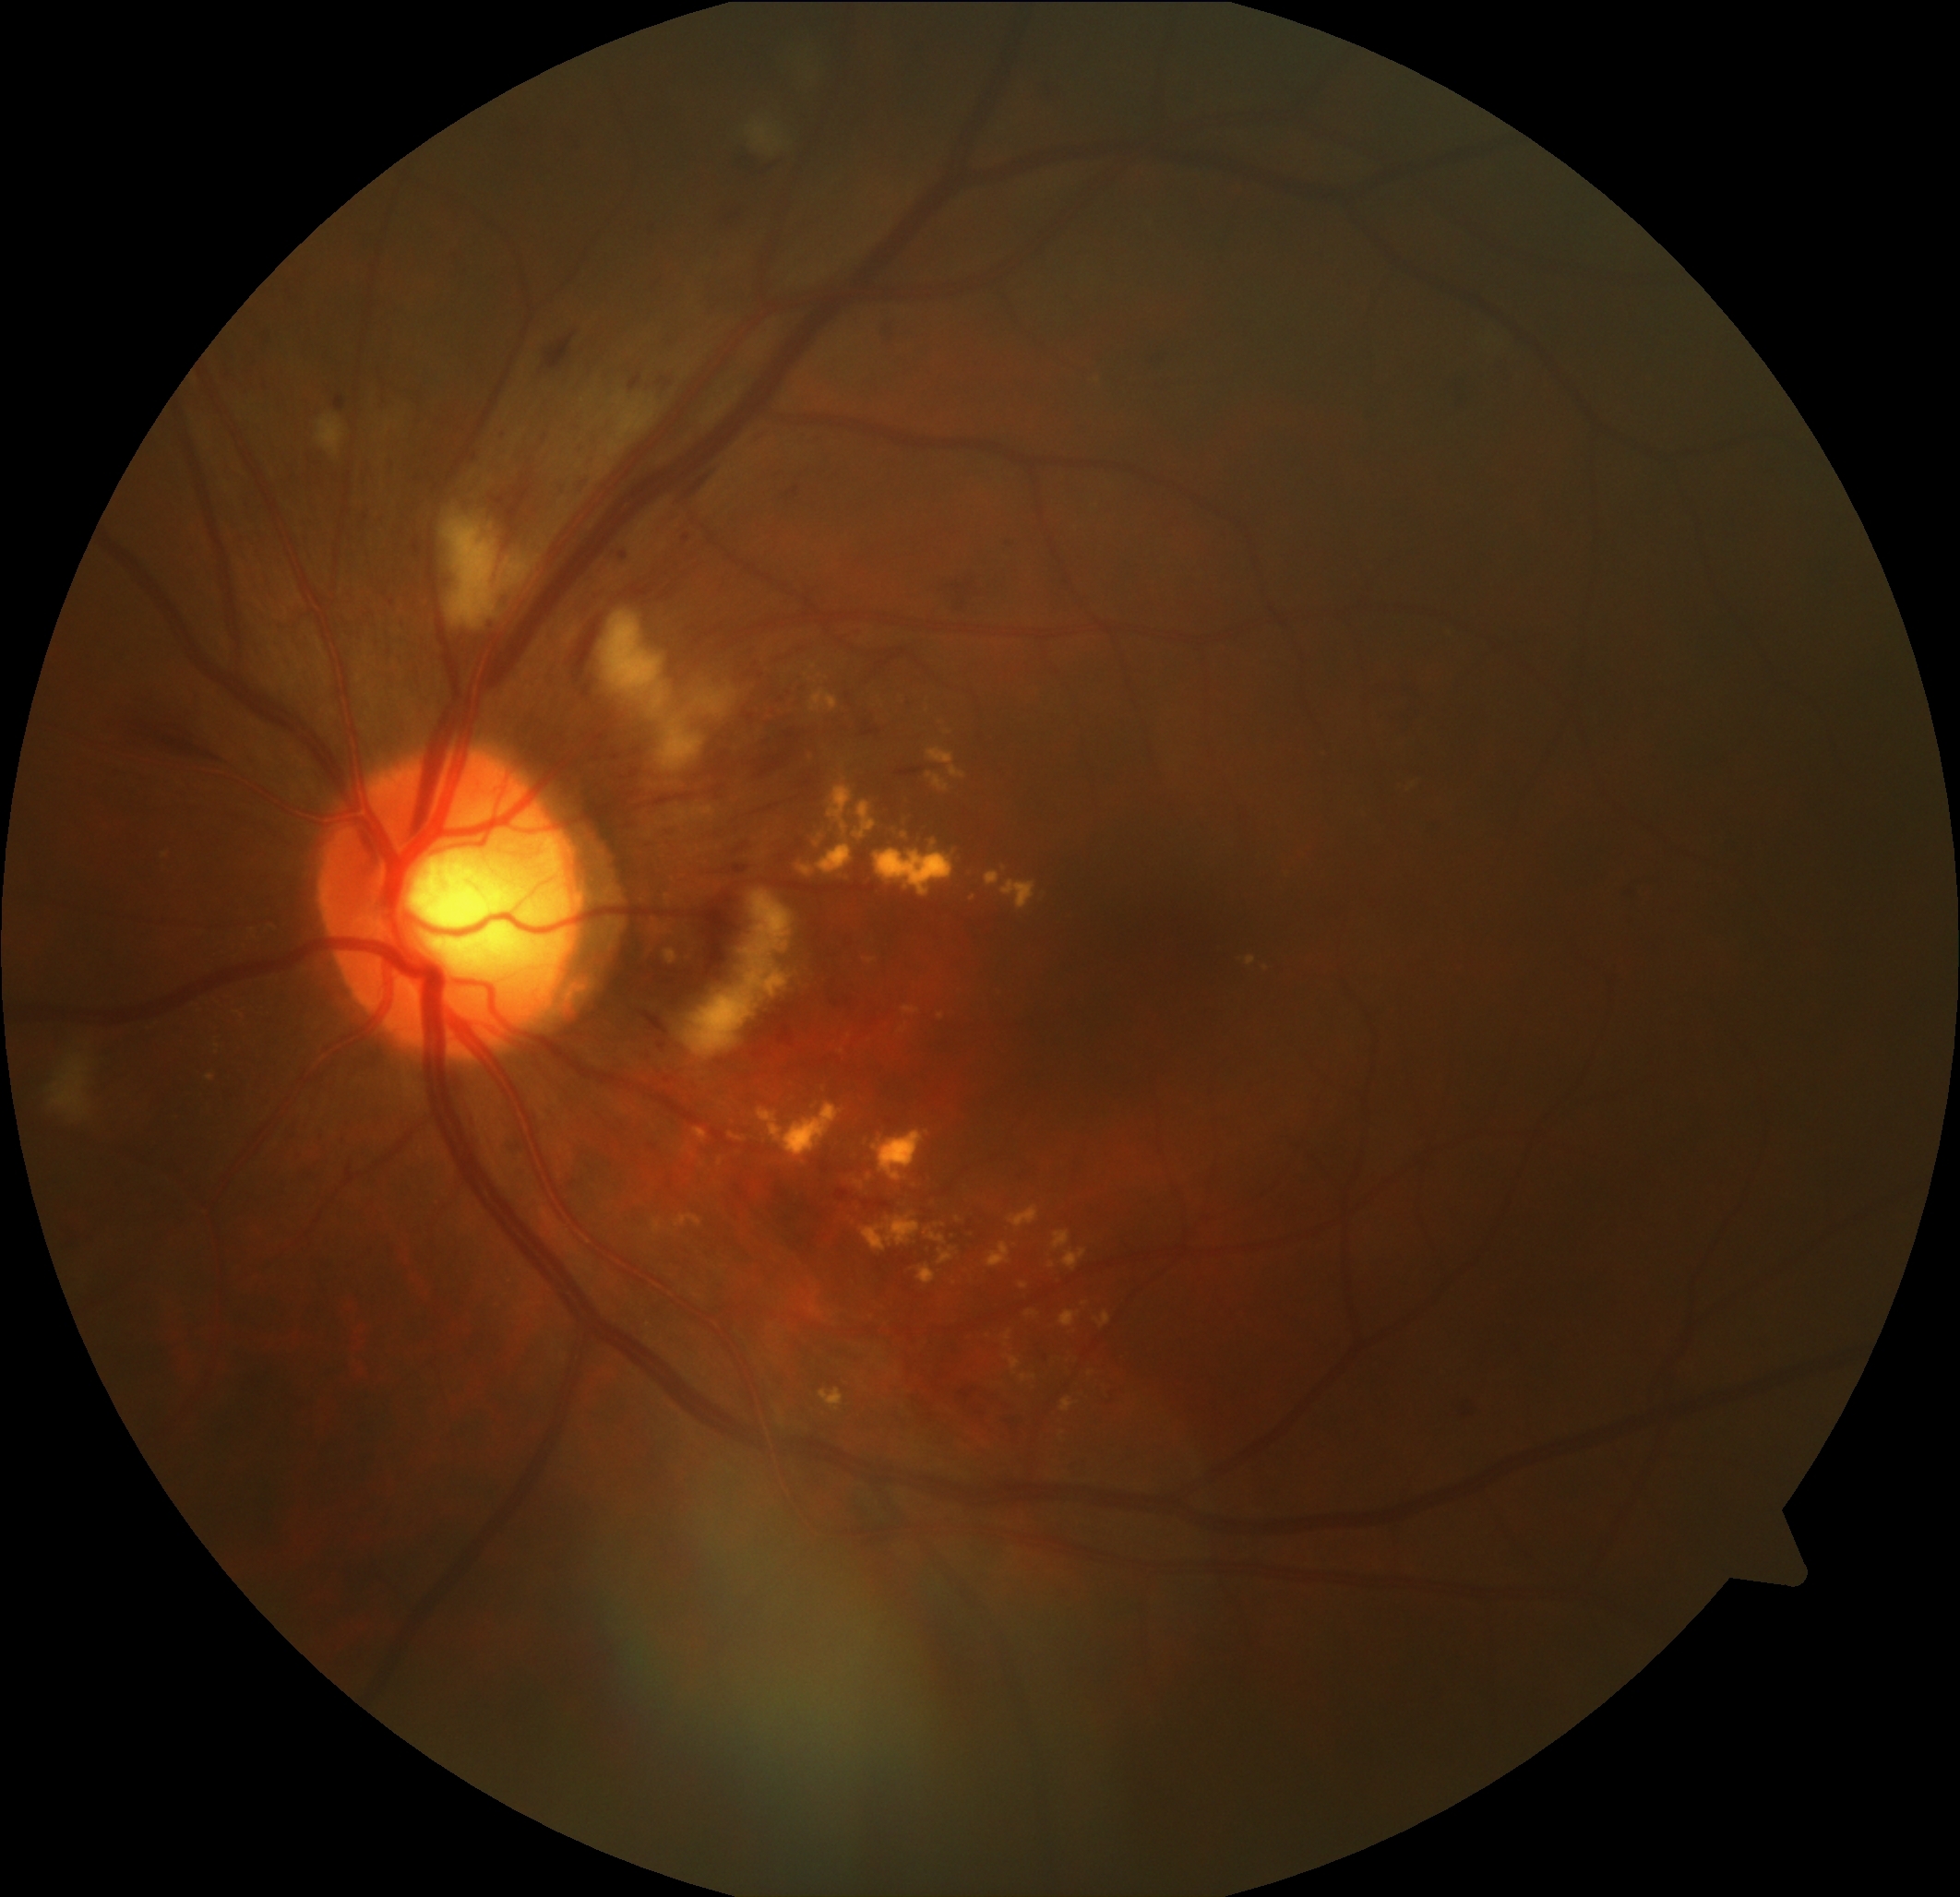
Annotations:
* DR class: non-proliferative diabetic retinopathy
* diabetic retinopathy (DR): grade 2 (moderate NPDR)